RetCam wide-field infant fundus image:
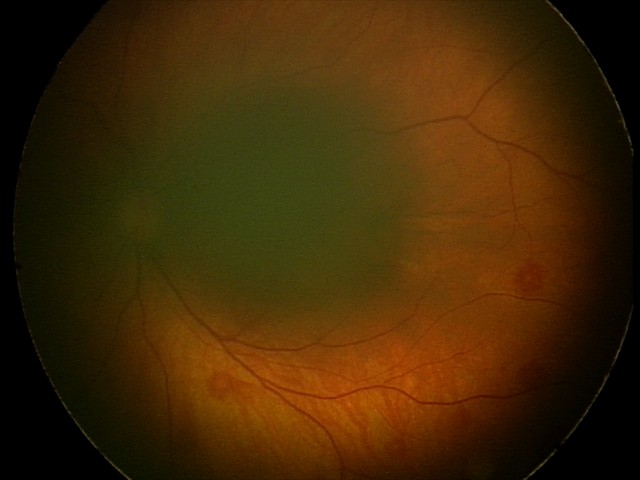

Q: What was the screening finding?
A: retinal hemorrhages